Nonmydriatic, 45-degree field of view, modified Davis grading.
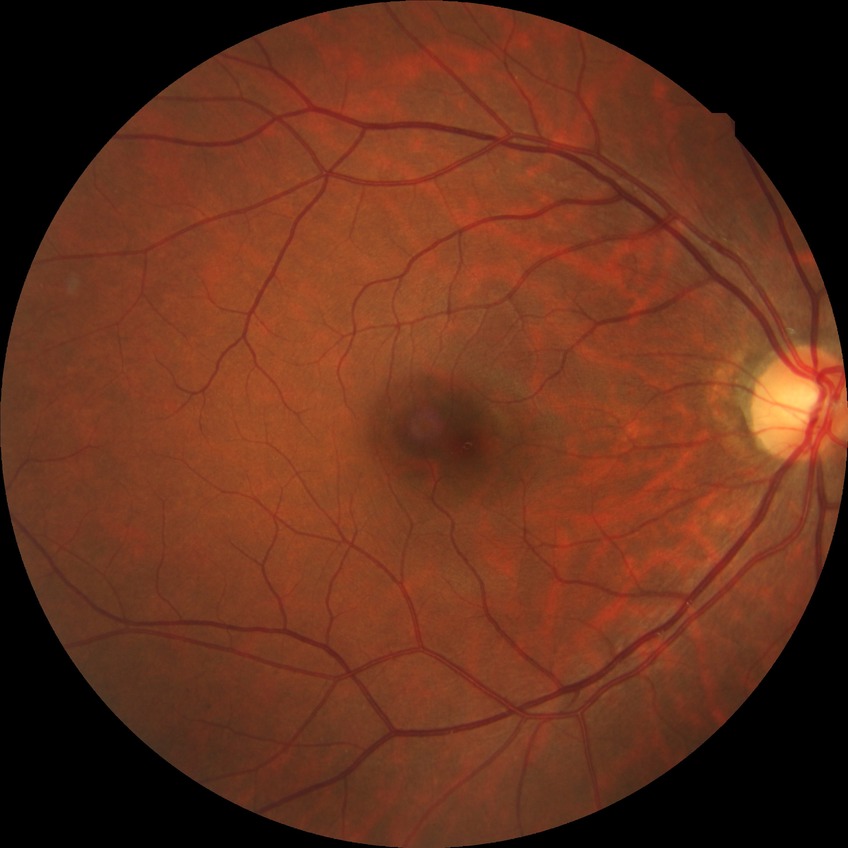 Diabetic retinopathy (DR) is NDR (no diabetic retinopathy).